Camera: Clarity RetCam 3 (130° FOV) · pediatric wide-field fundus photograph — 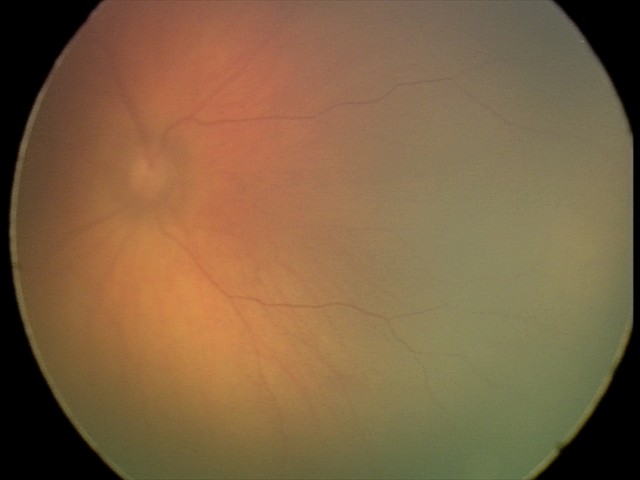
Screening examination diagnosed as physiological.